Fundus photo, FOV: 45 degrees — 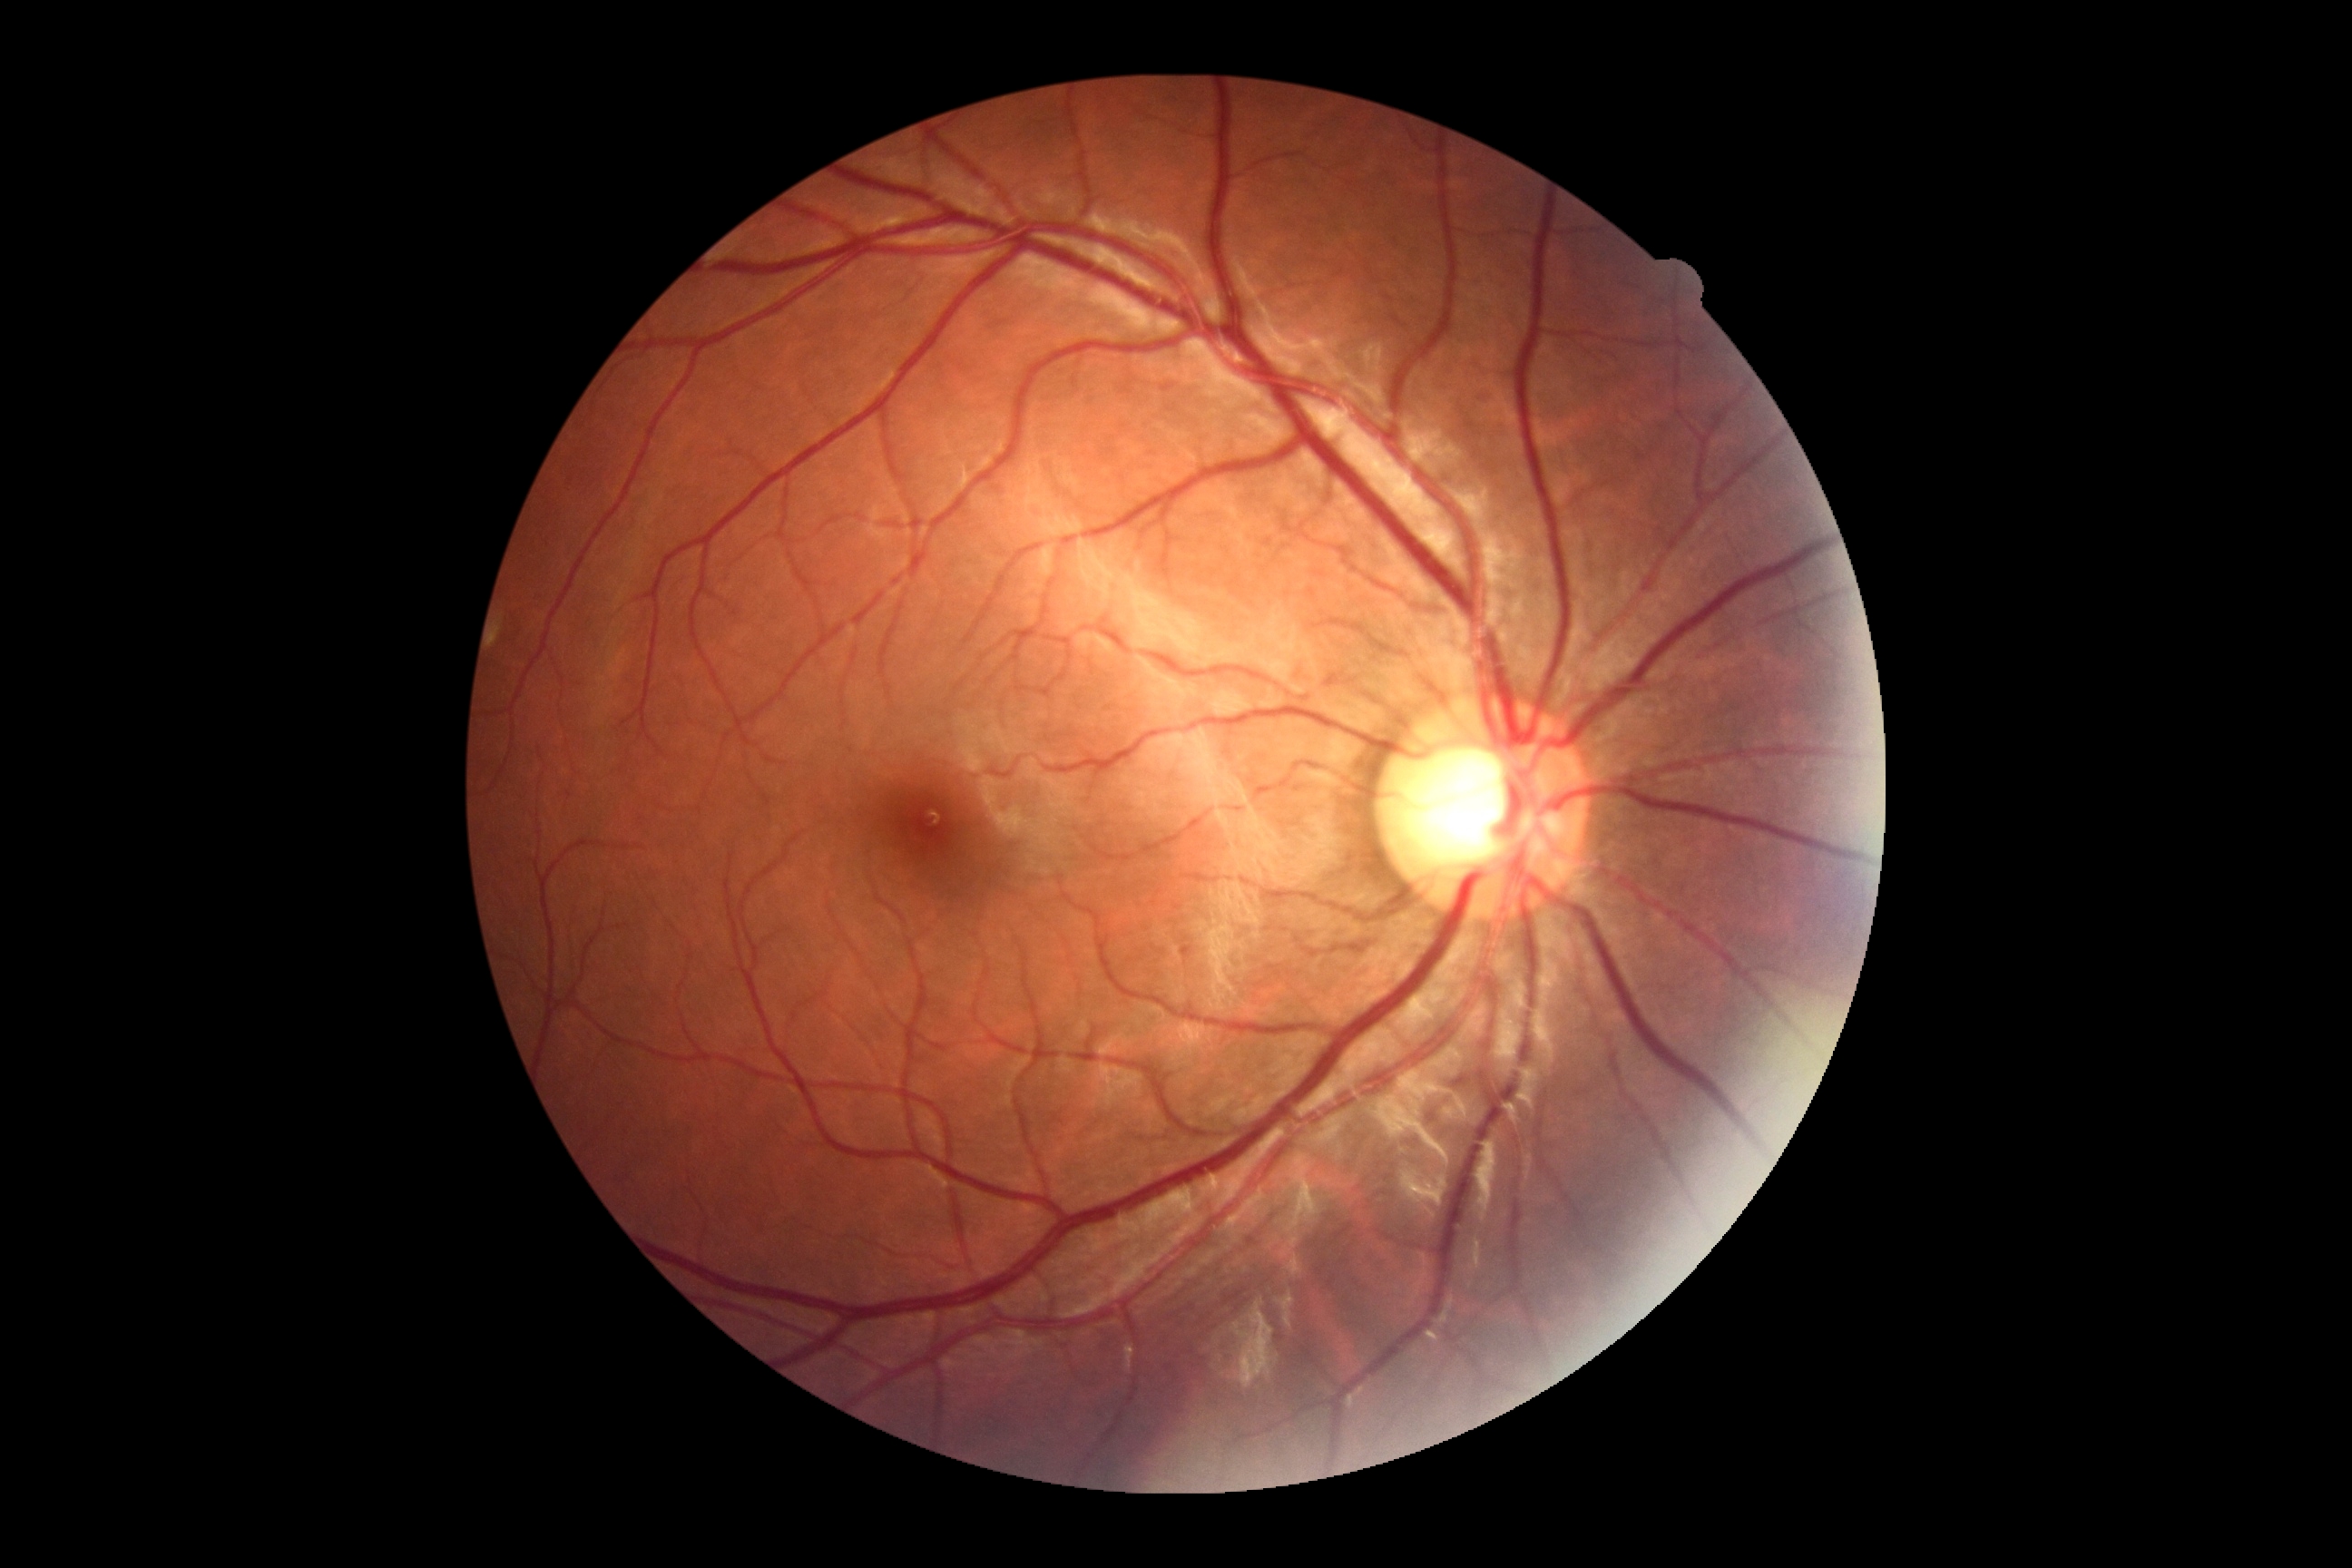 No signs of diabetic retinopathy. Diabetic retinopathy severity: grade 0 (no apparent retinopathy).